Camera: Topcon TRC-50DX — 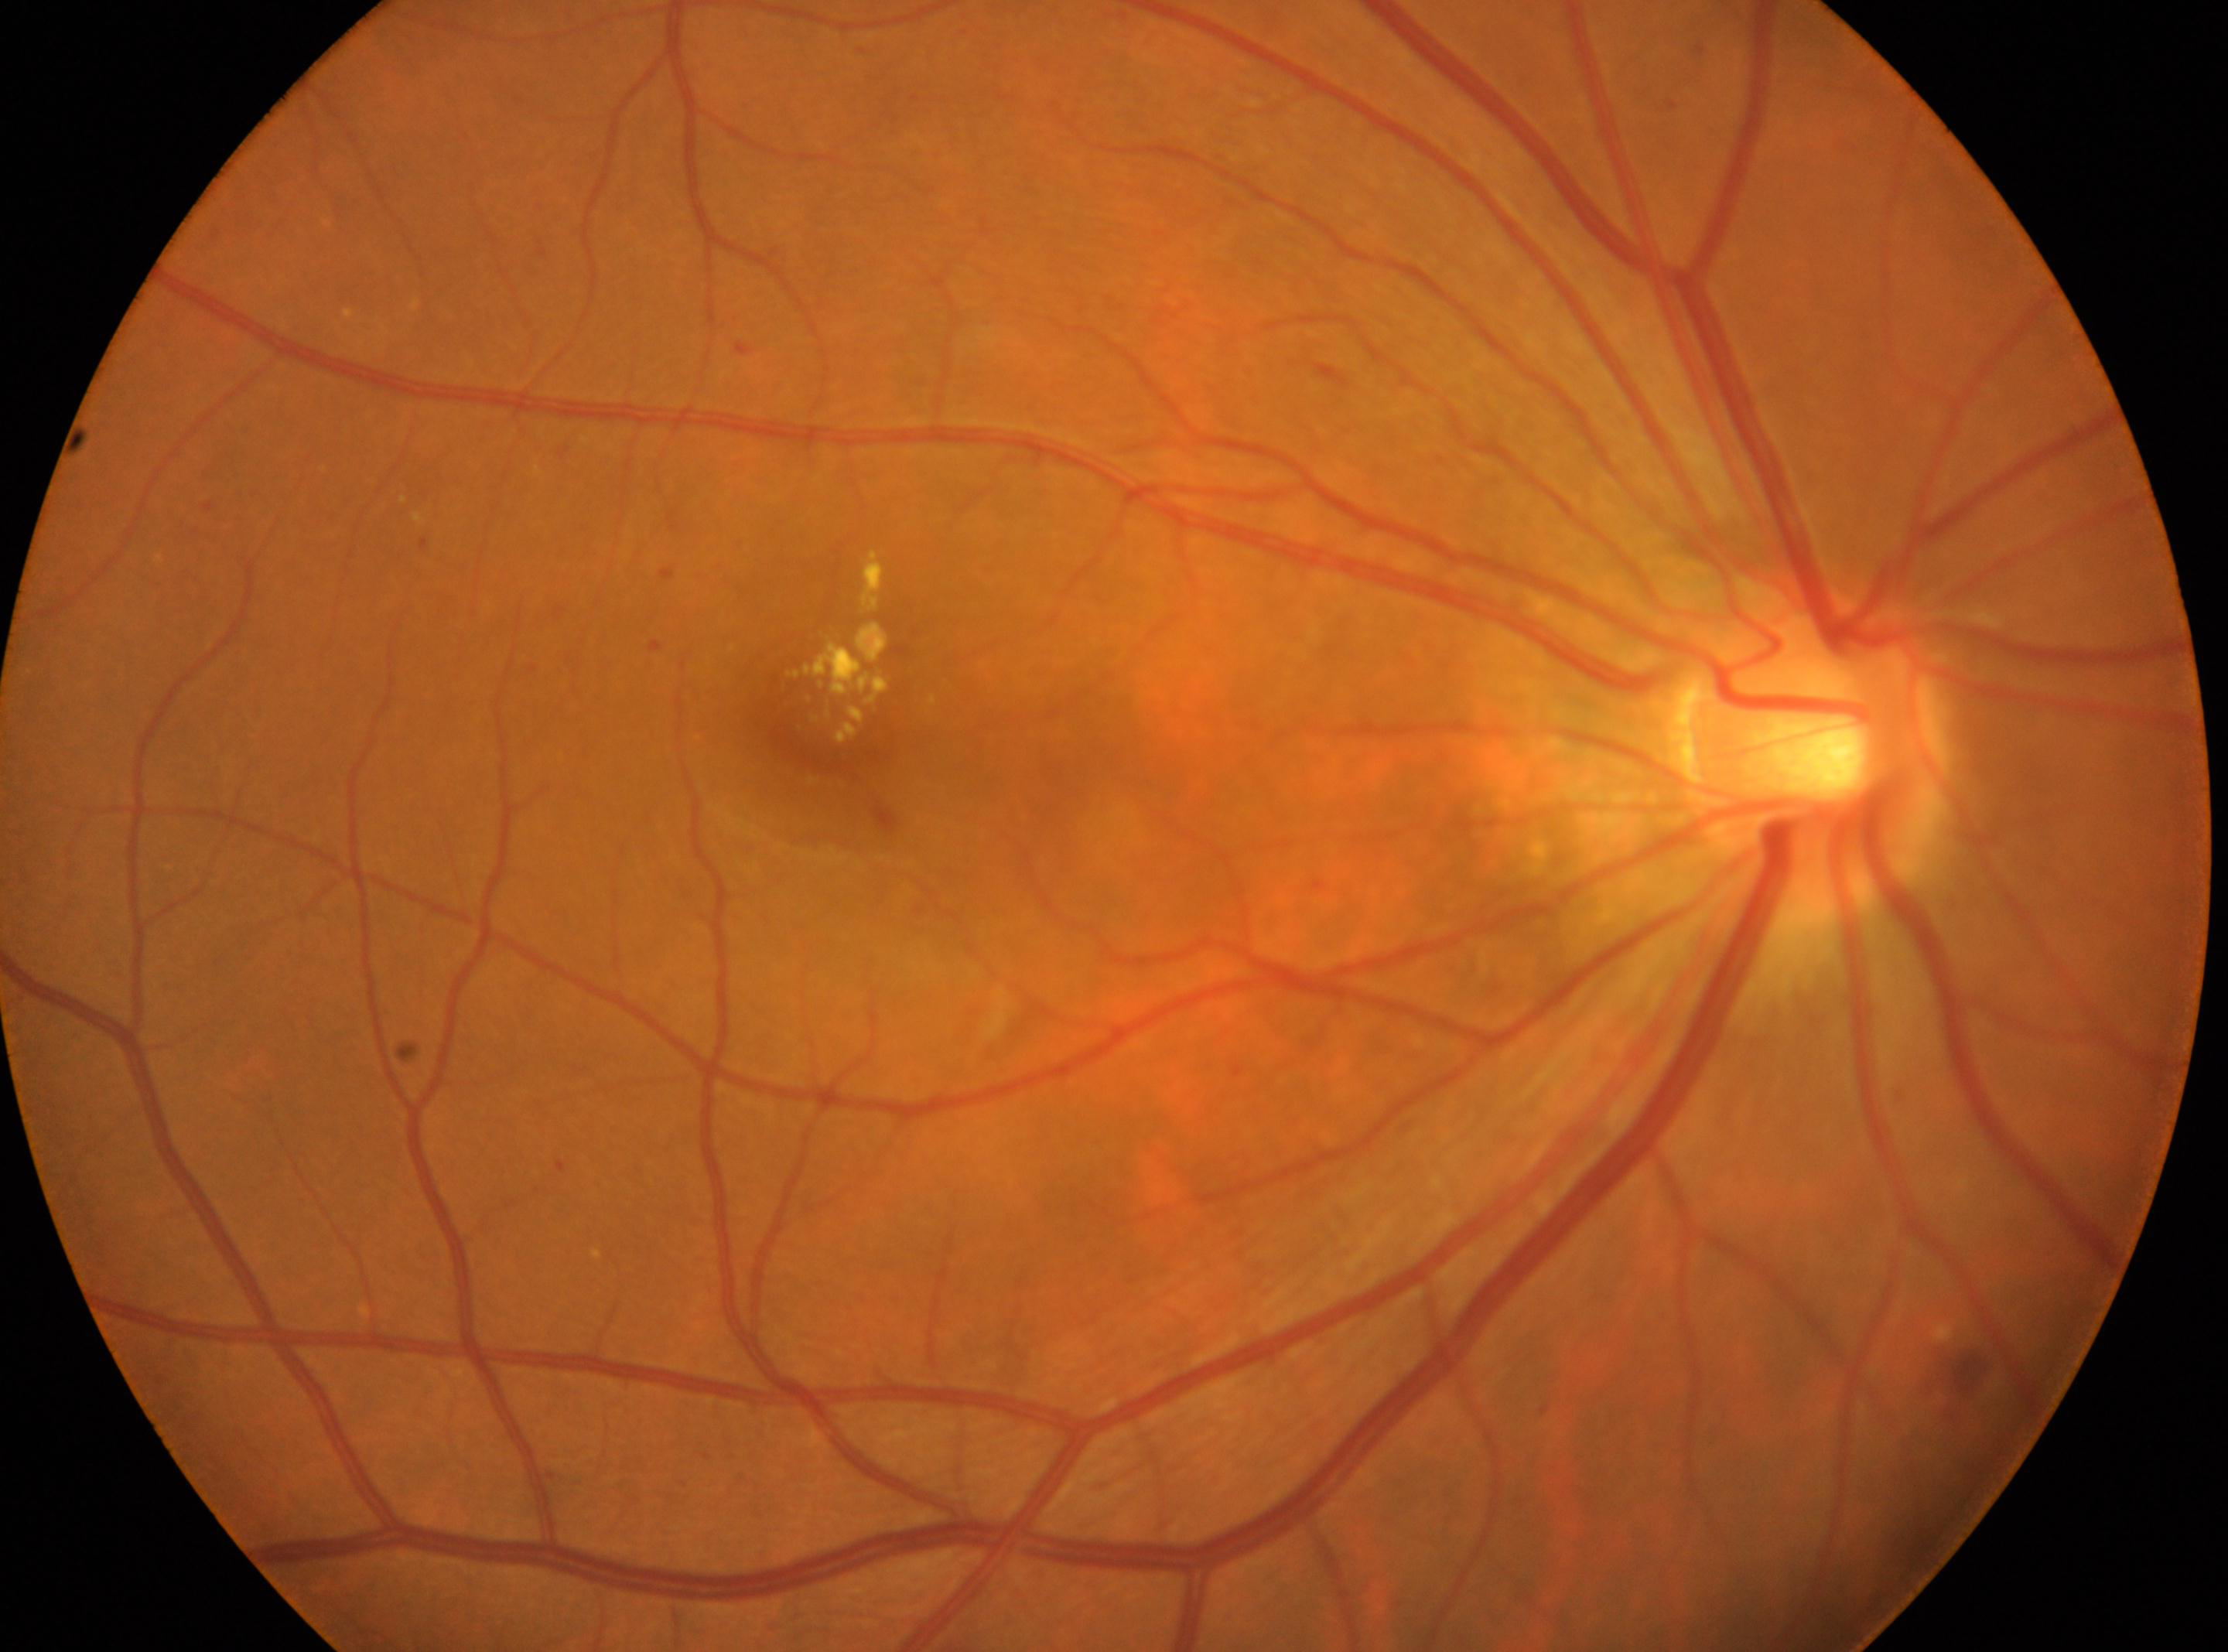 retinopathy grade = moderate NPDR (2); foveal center = x=817, y=716; laterality = right; optic disc = x=1809, y=750.